848x848; without pupil dilation:
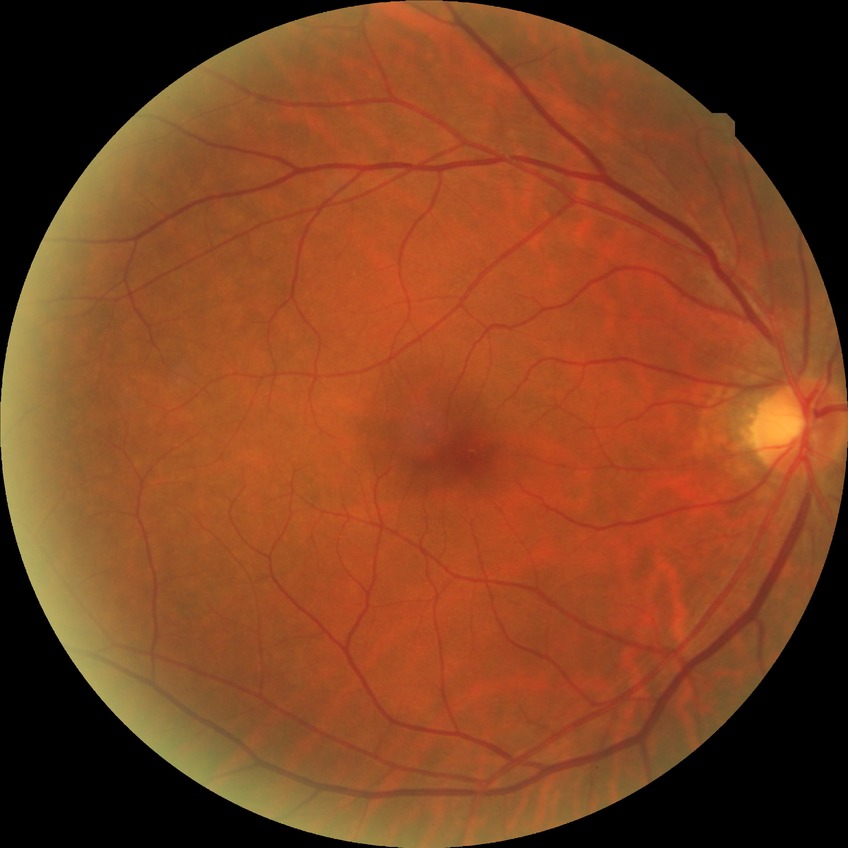

DR grade@NDR.